Pediatric retinal photograph (wide-field).
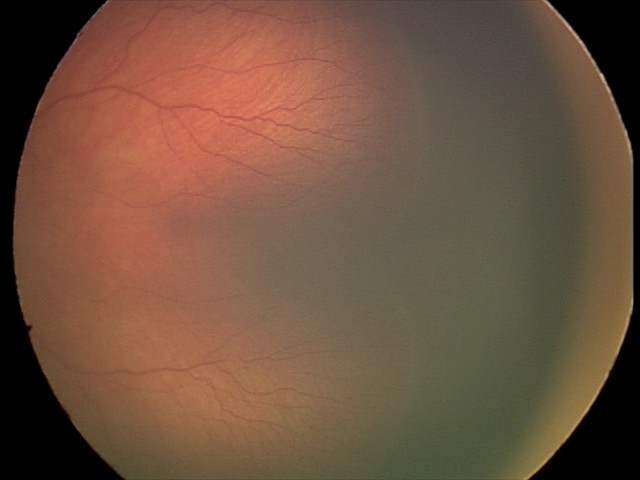
Impression = ROP stage 2.